Diabetic retinopathy graded by the modified Davis classification — 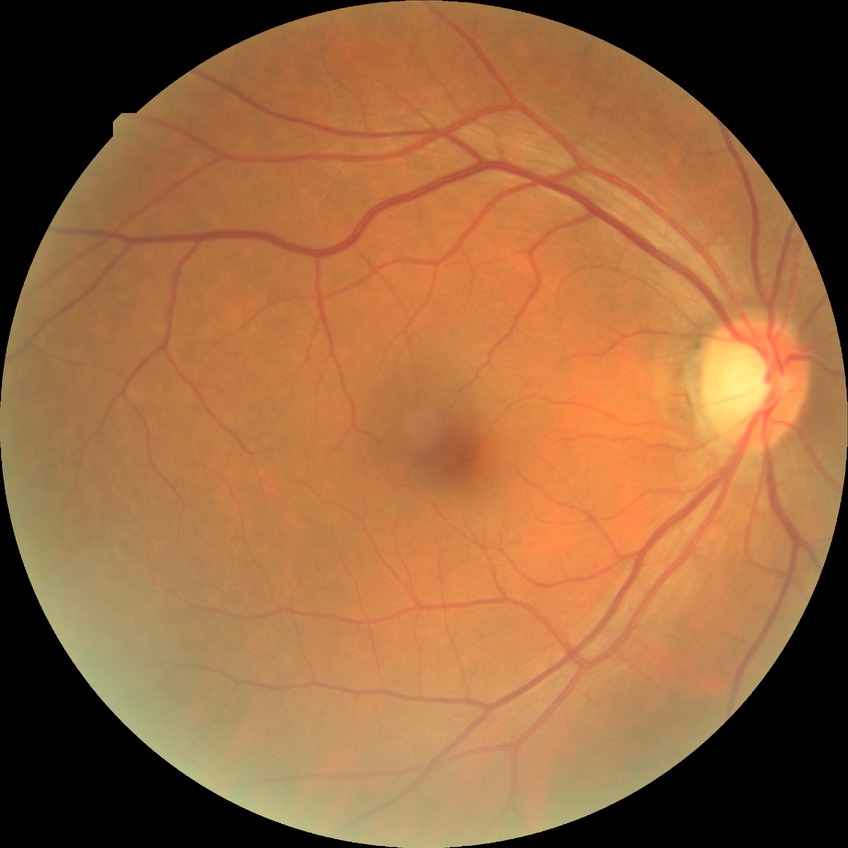
Retinopathy stage: no diabetic retinopathy.